Retinal fundus photograph, NIDEK AFC-230
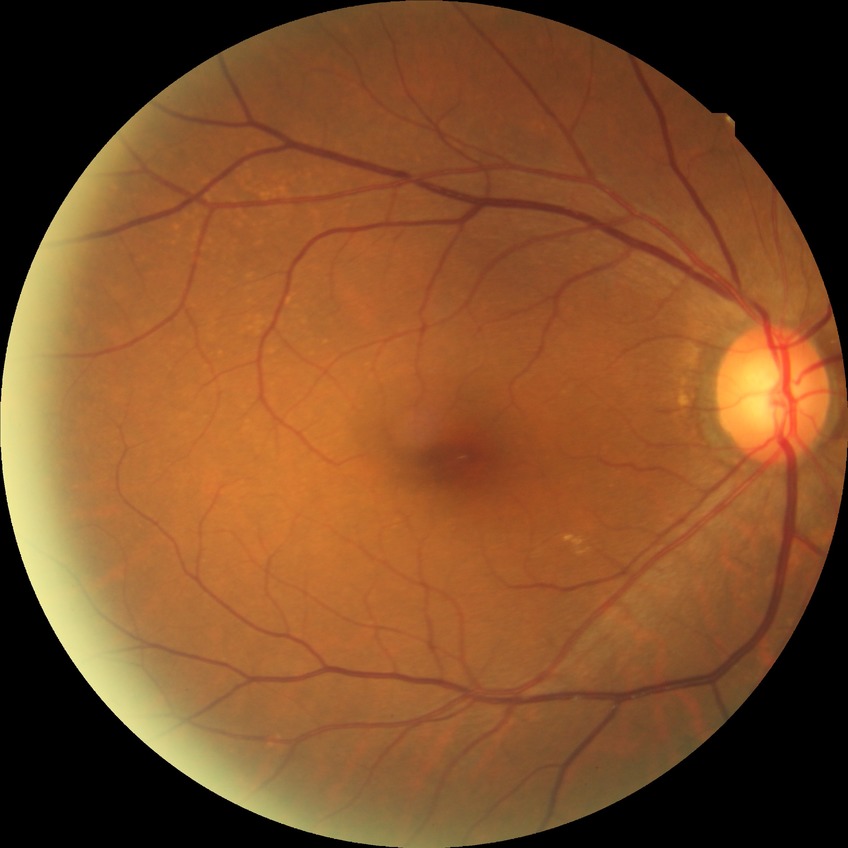
Diabetic retinopathy (DR) is NDR (no diabetic retinopathy).